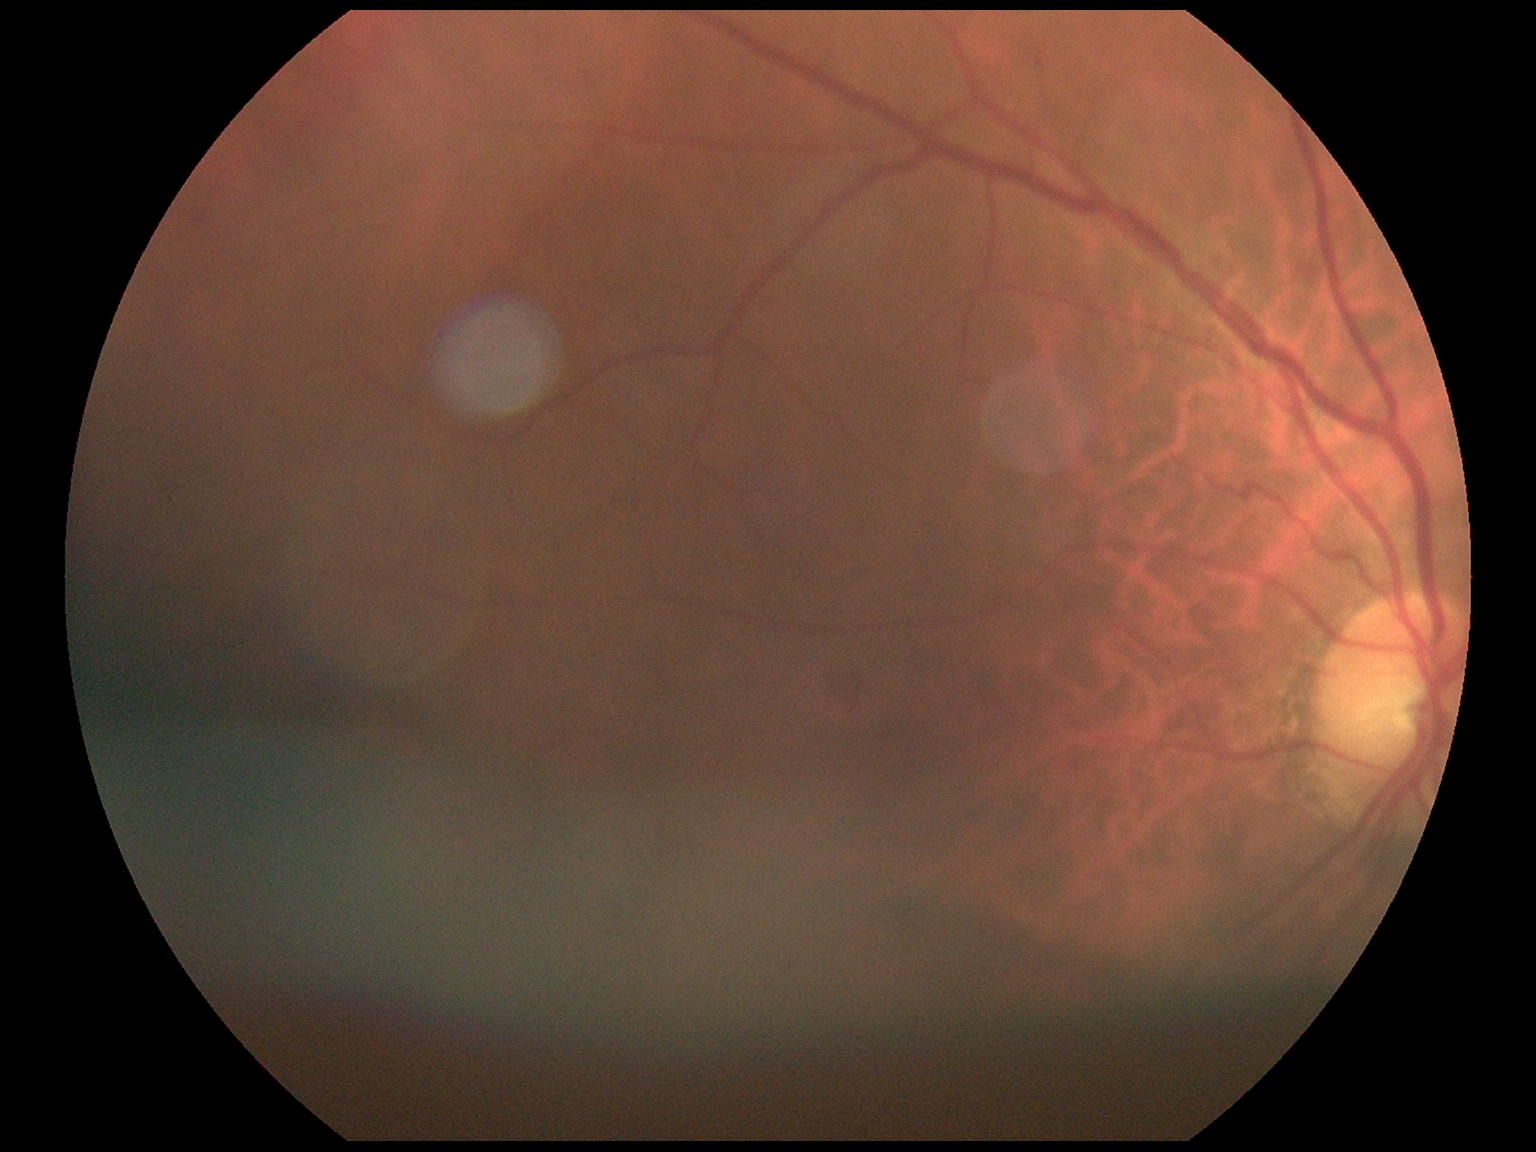
Diabetic retinopathy (DR): grade 2 (moderate NPDR).